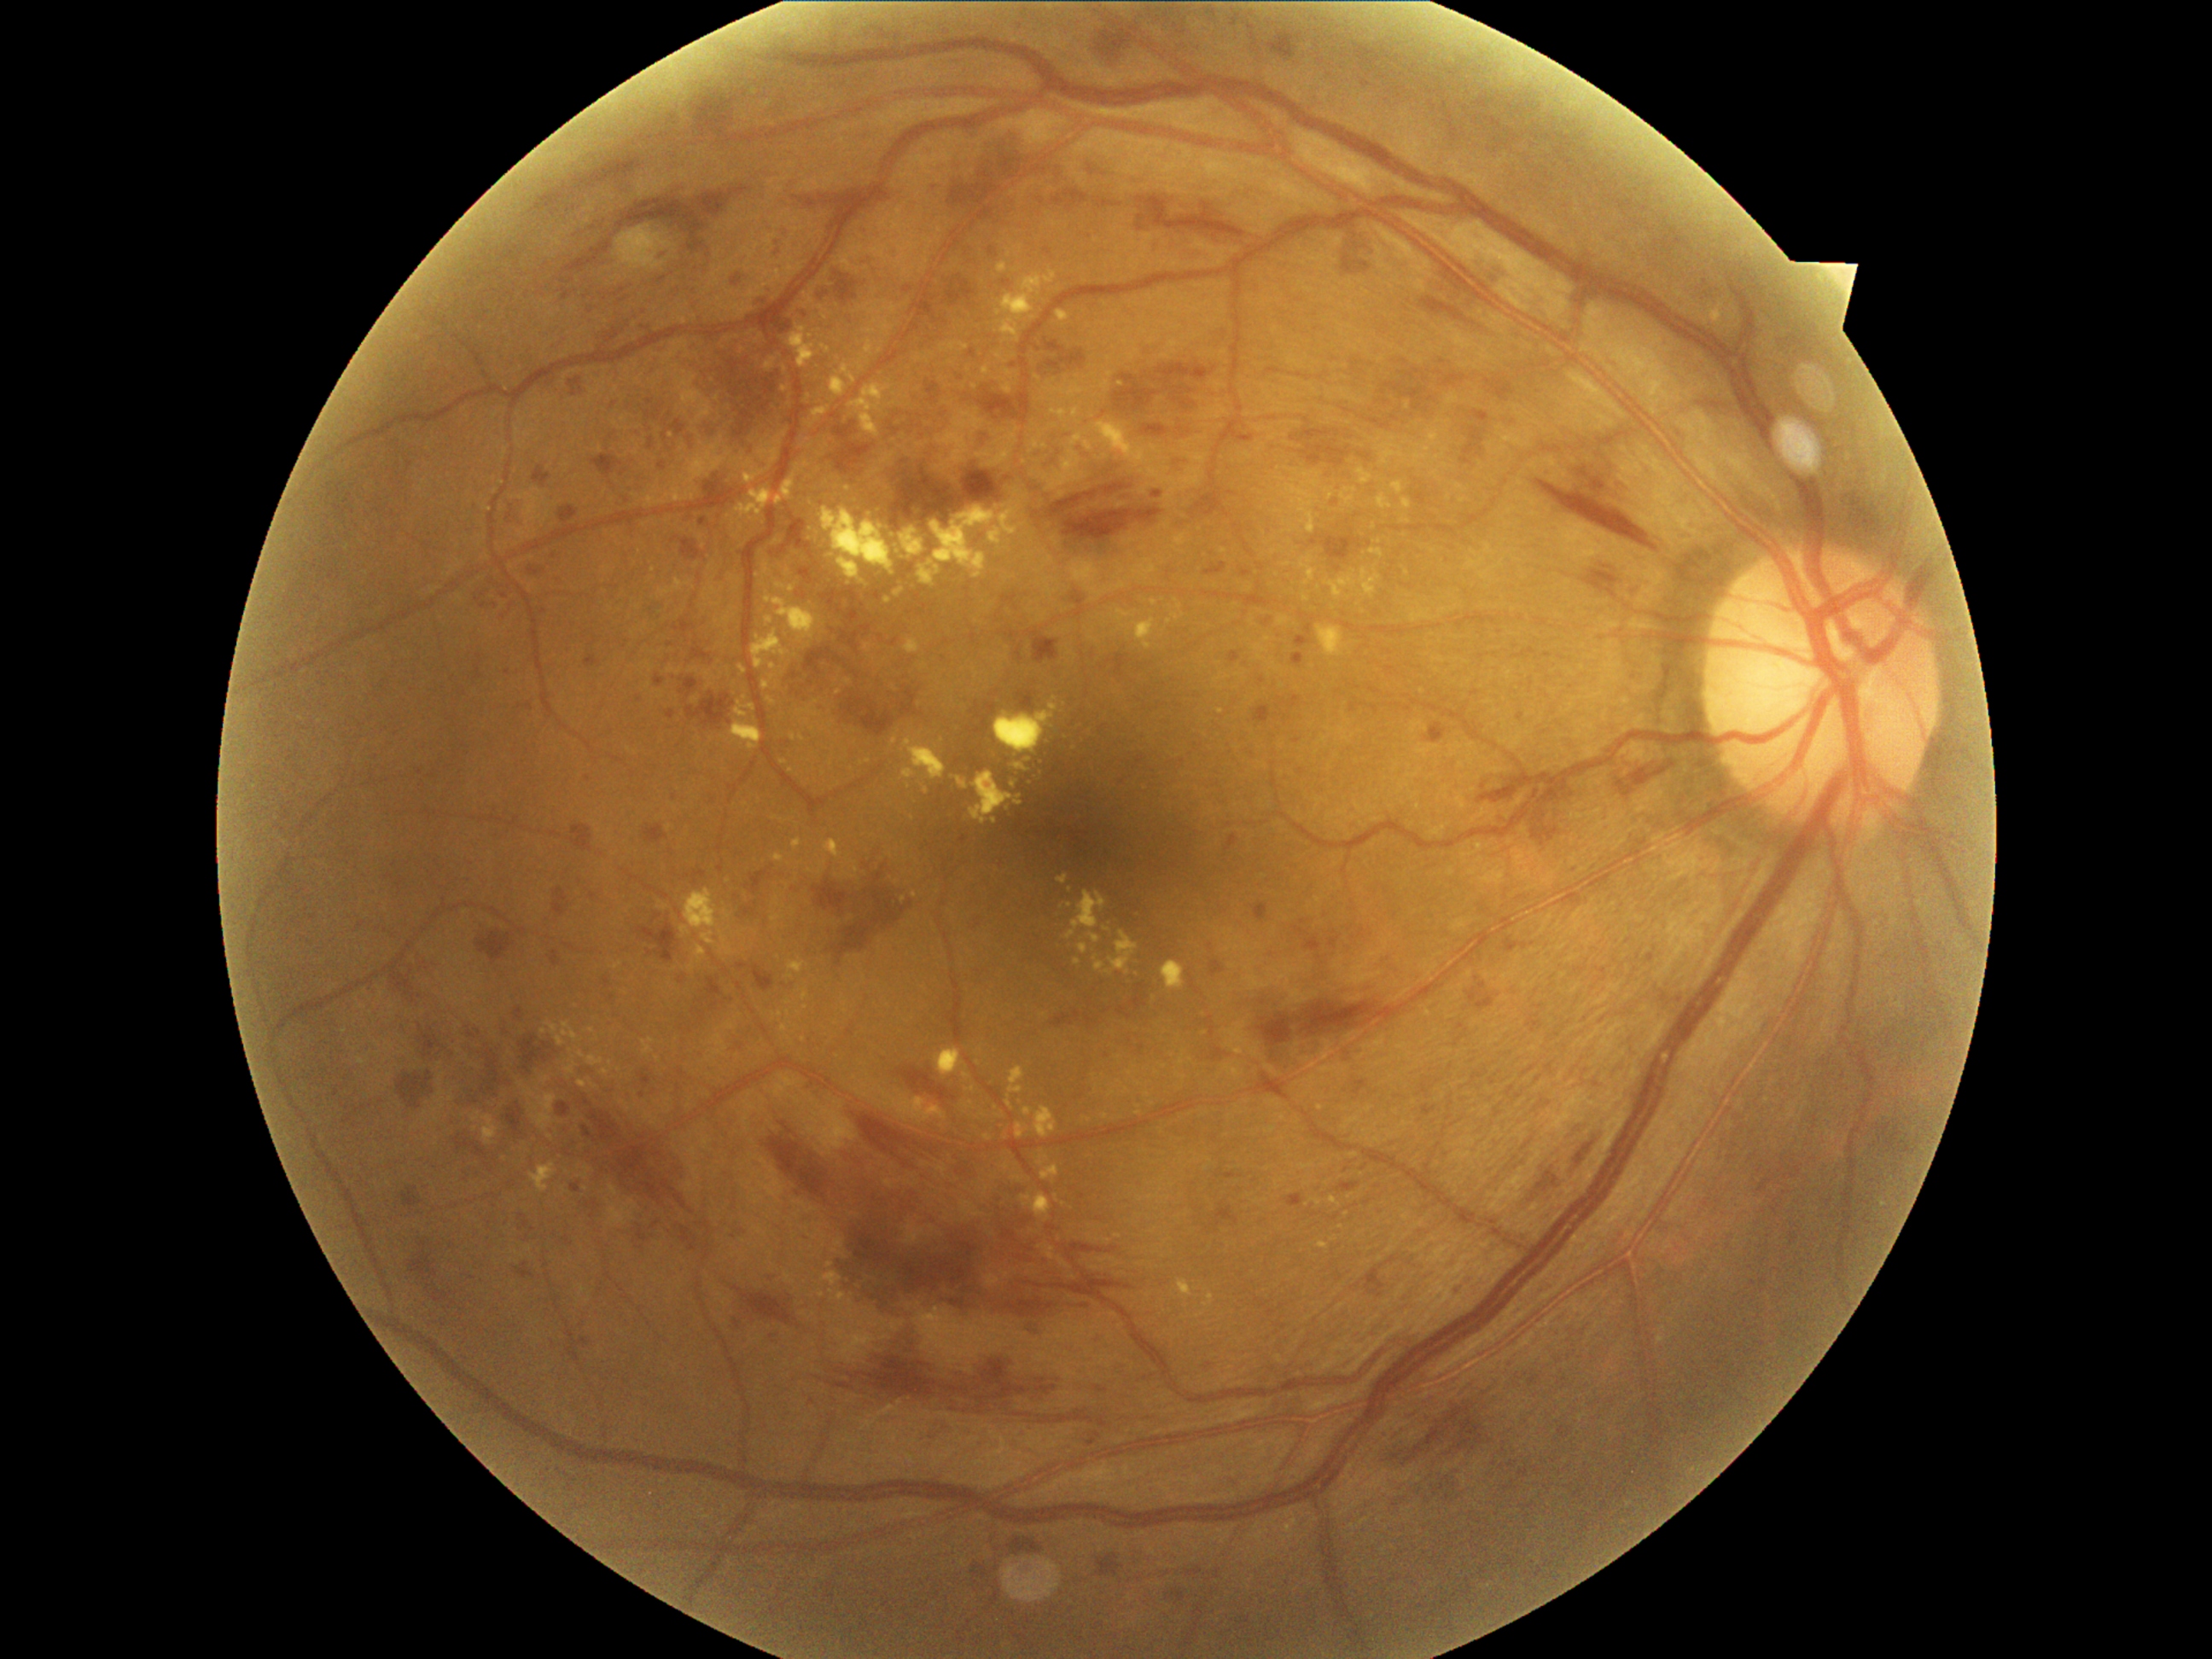 diabetic retinopathy grade@3 (severe NPDR), DR class@non-proliferative diabetic retinopathy.